45-degree field of view, color fundus image: 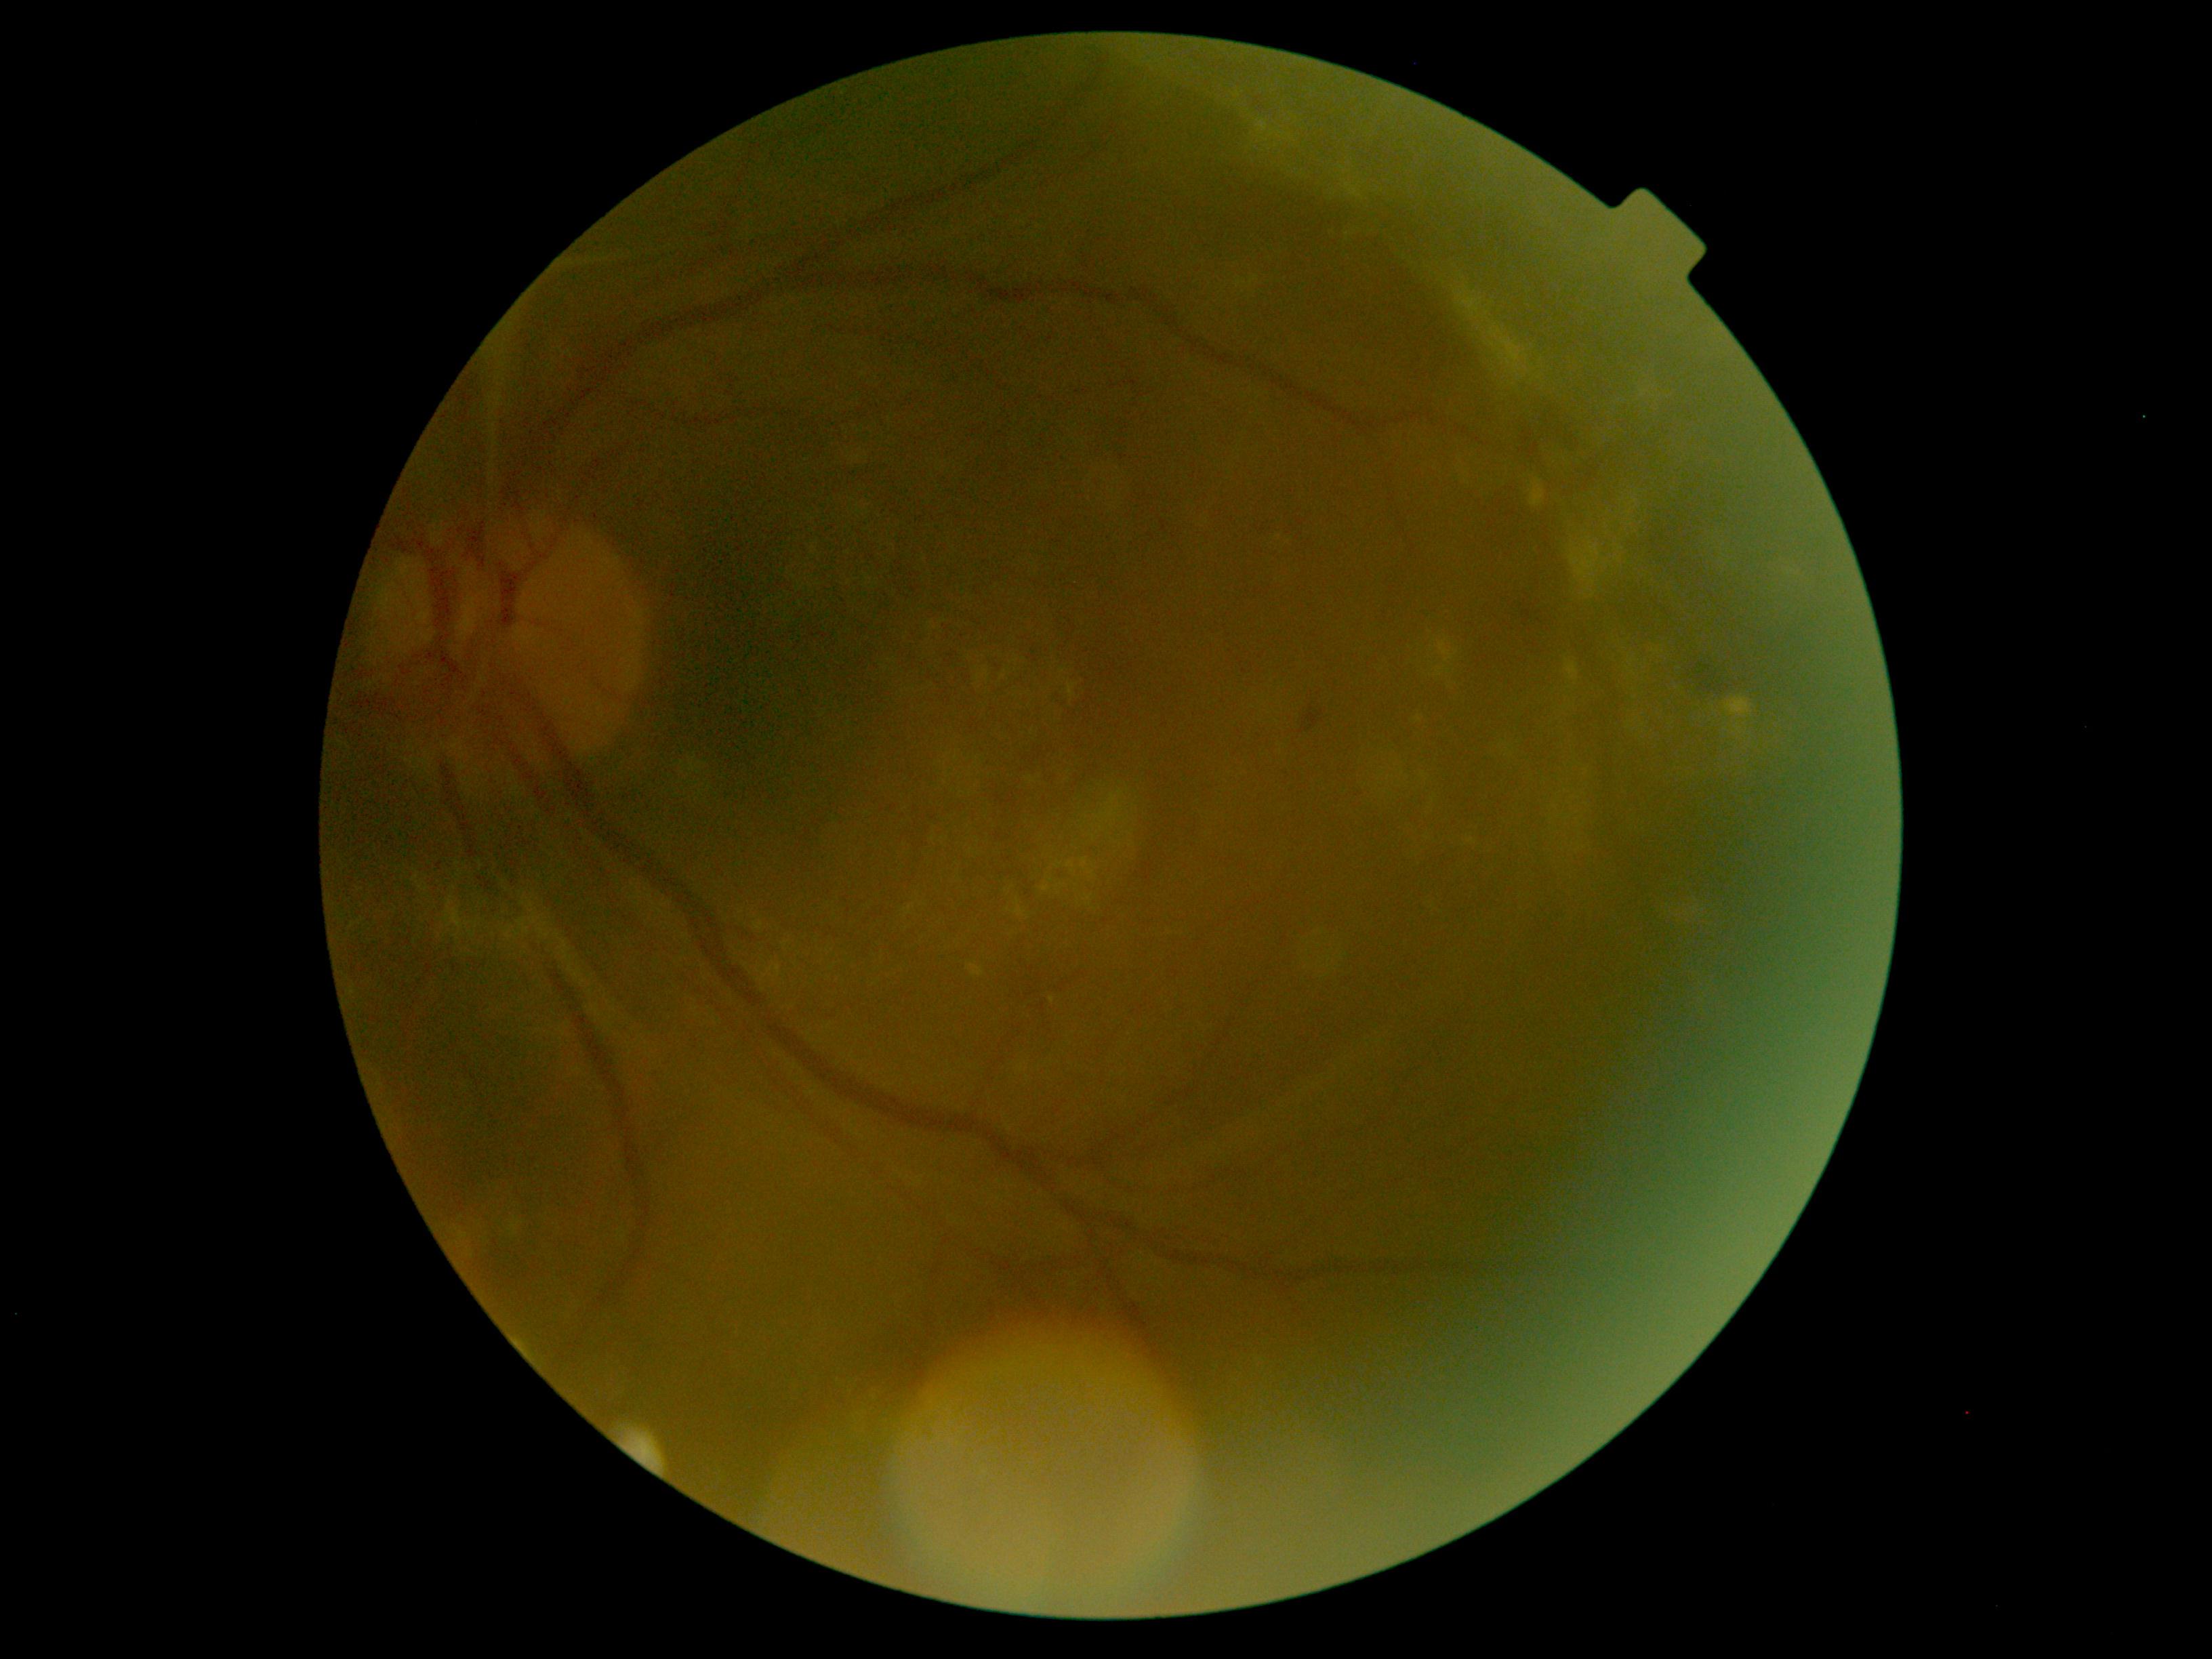 diabetic retinopathy severity: 4/4.